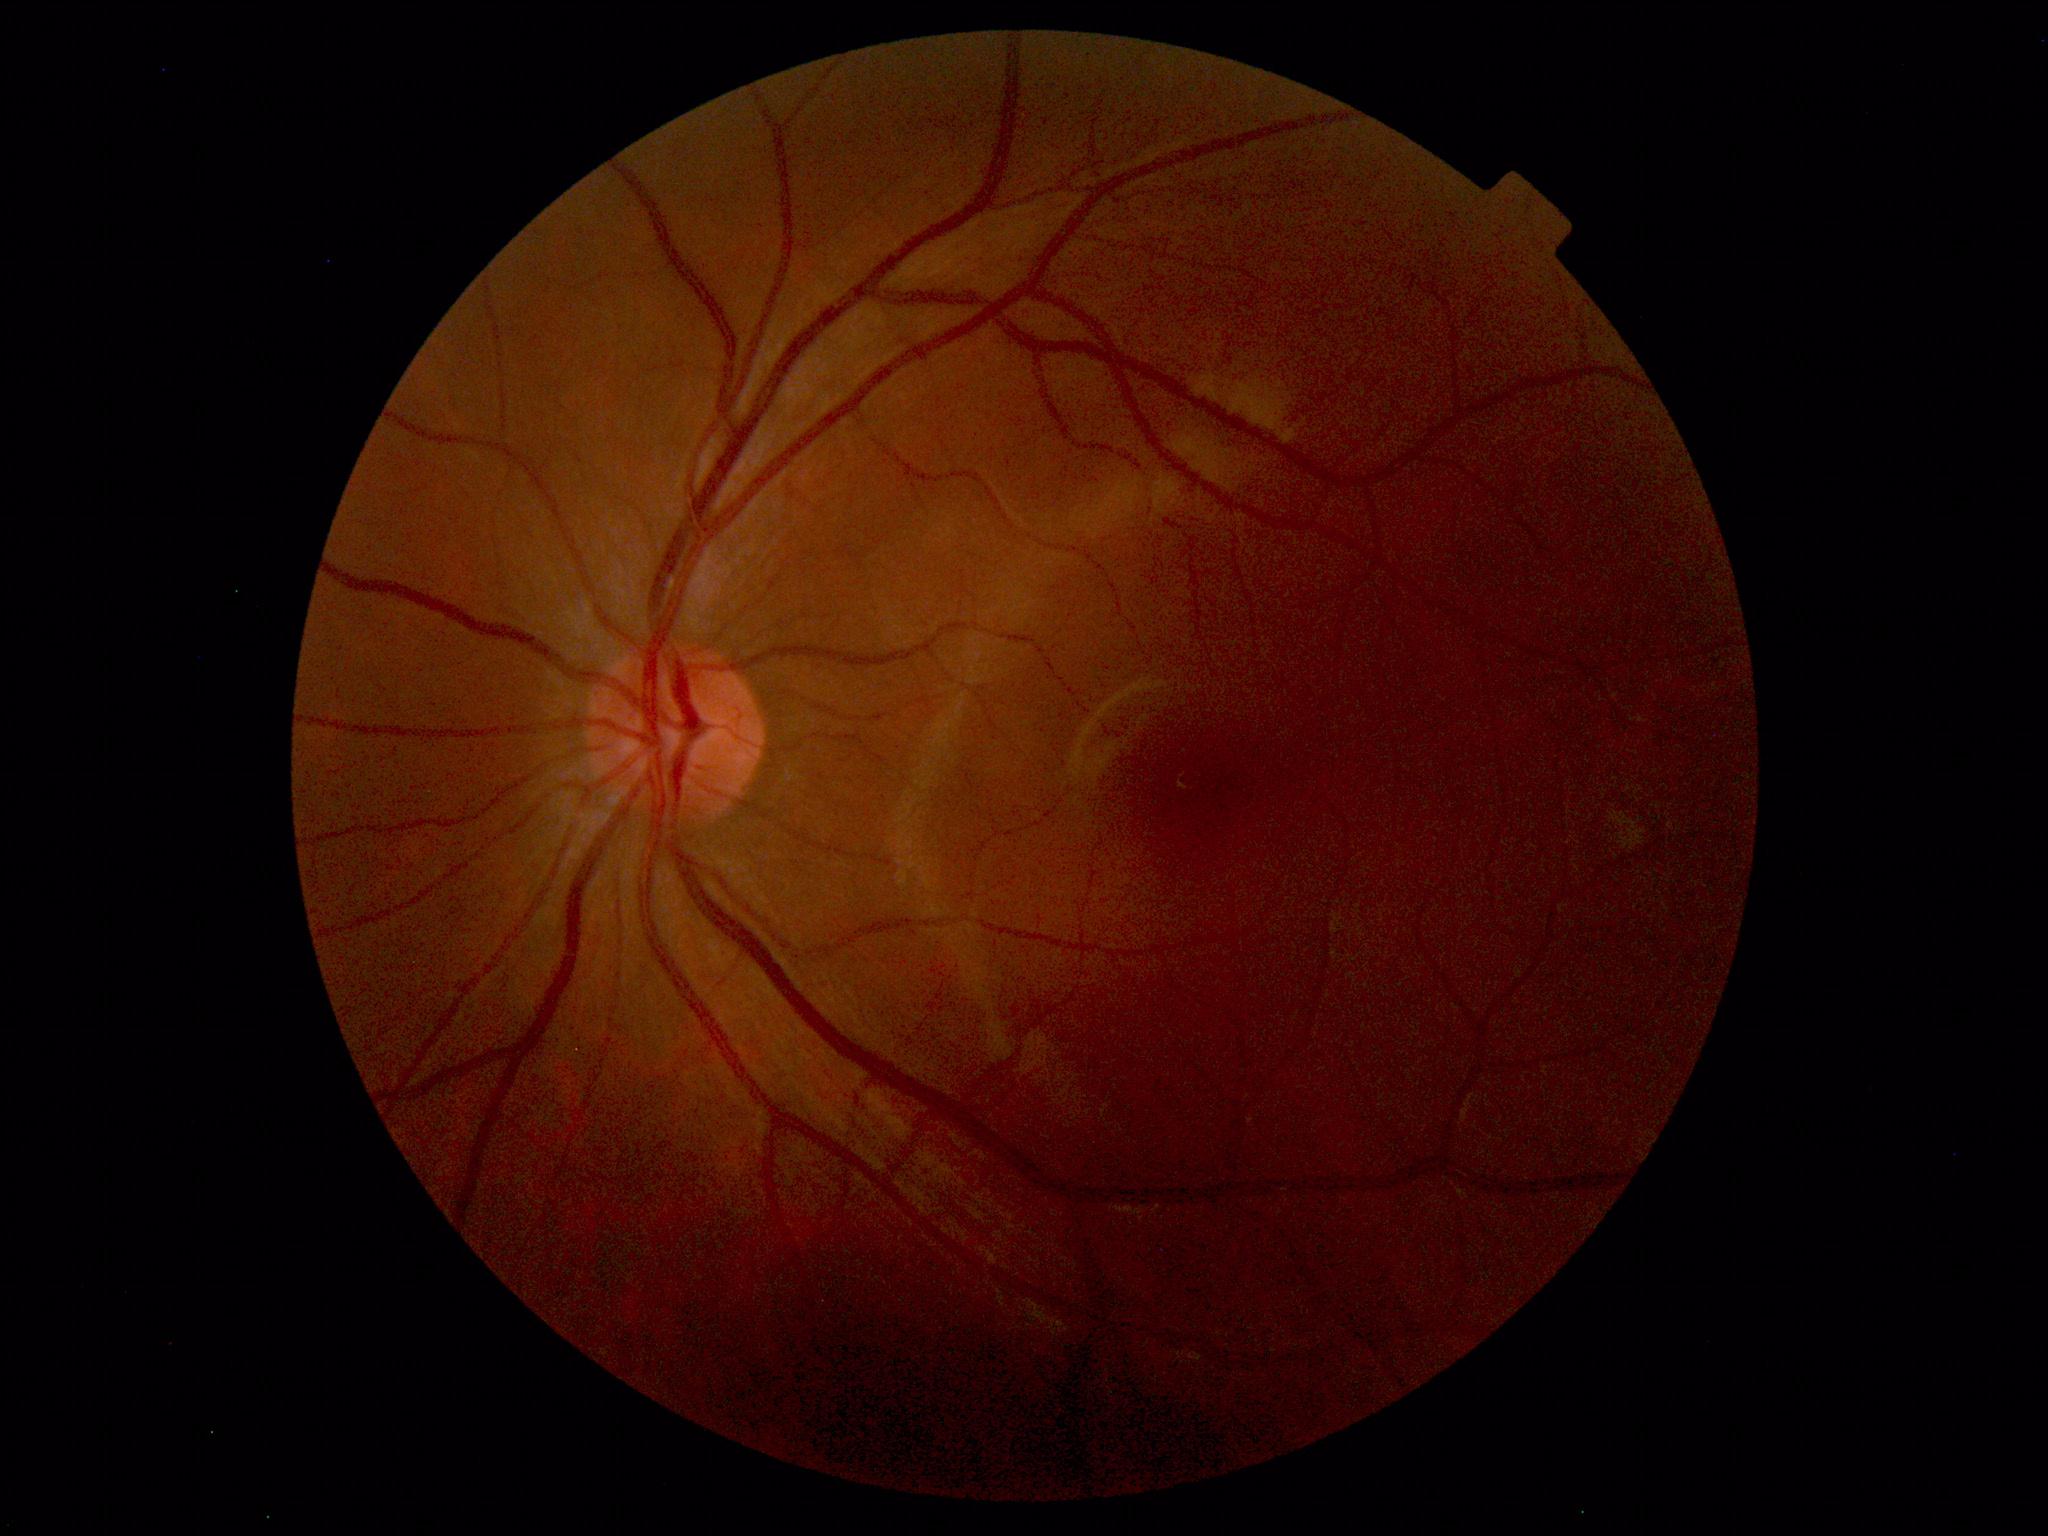

Diagnosis: normal.